2352 by 1568 pixels, CFP, 45° field of view: 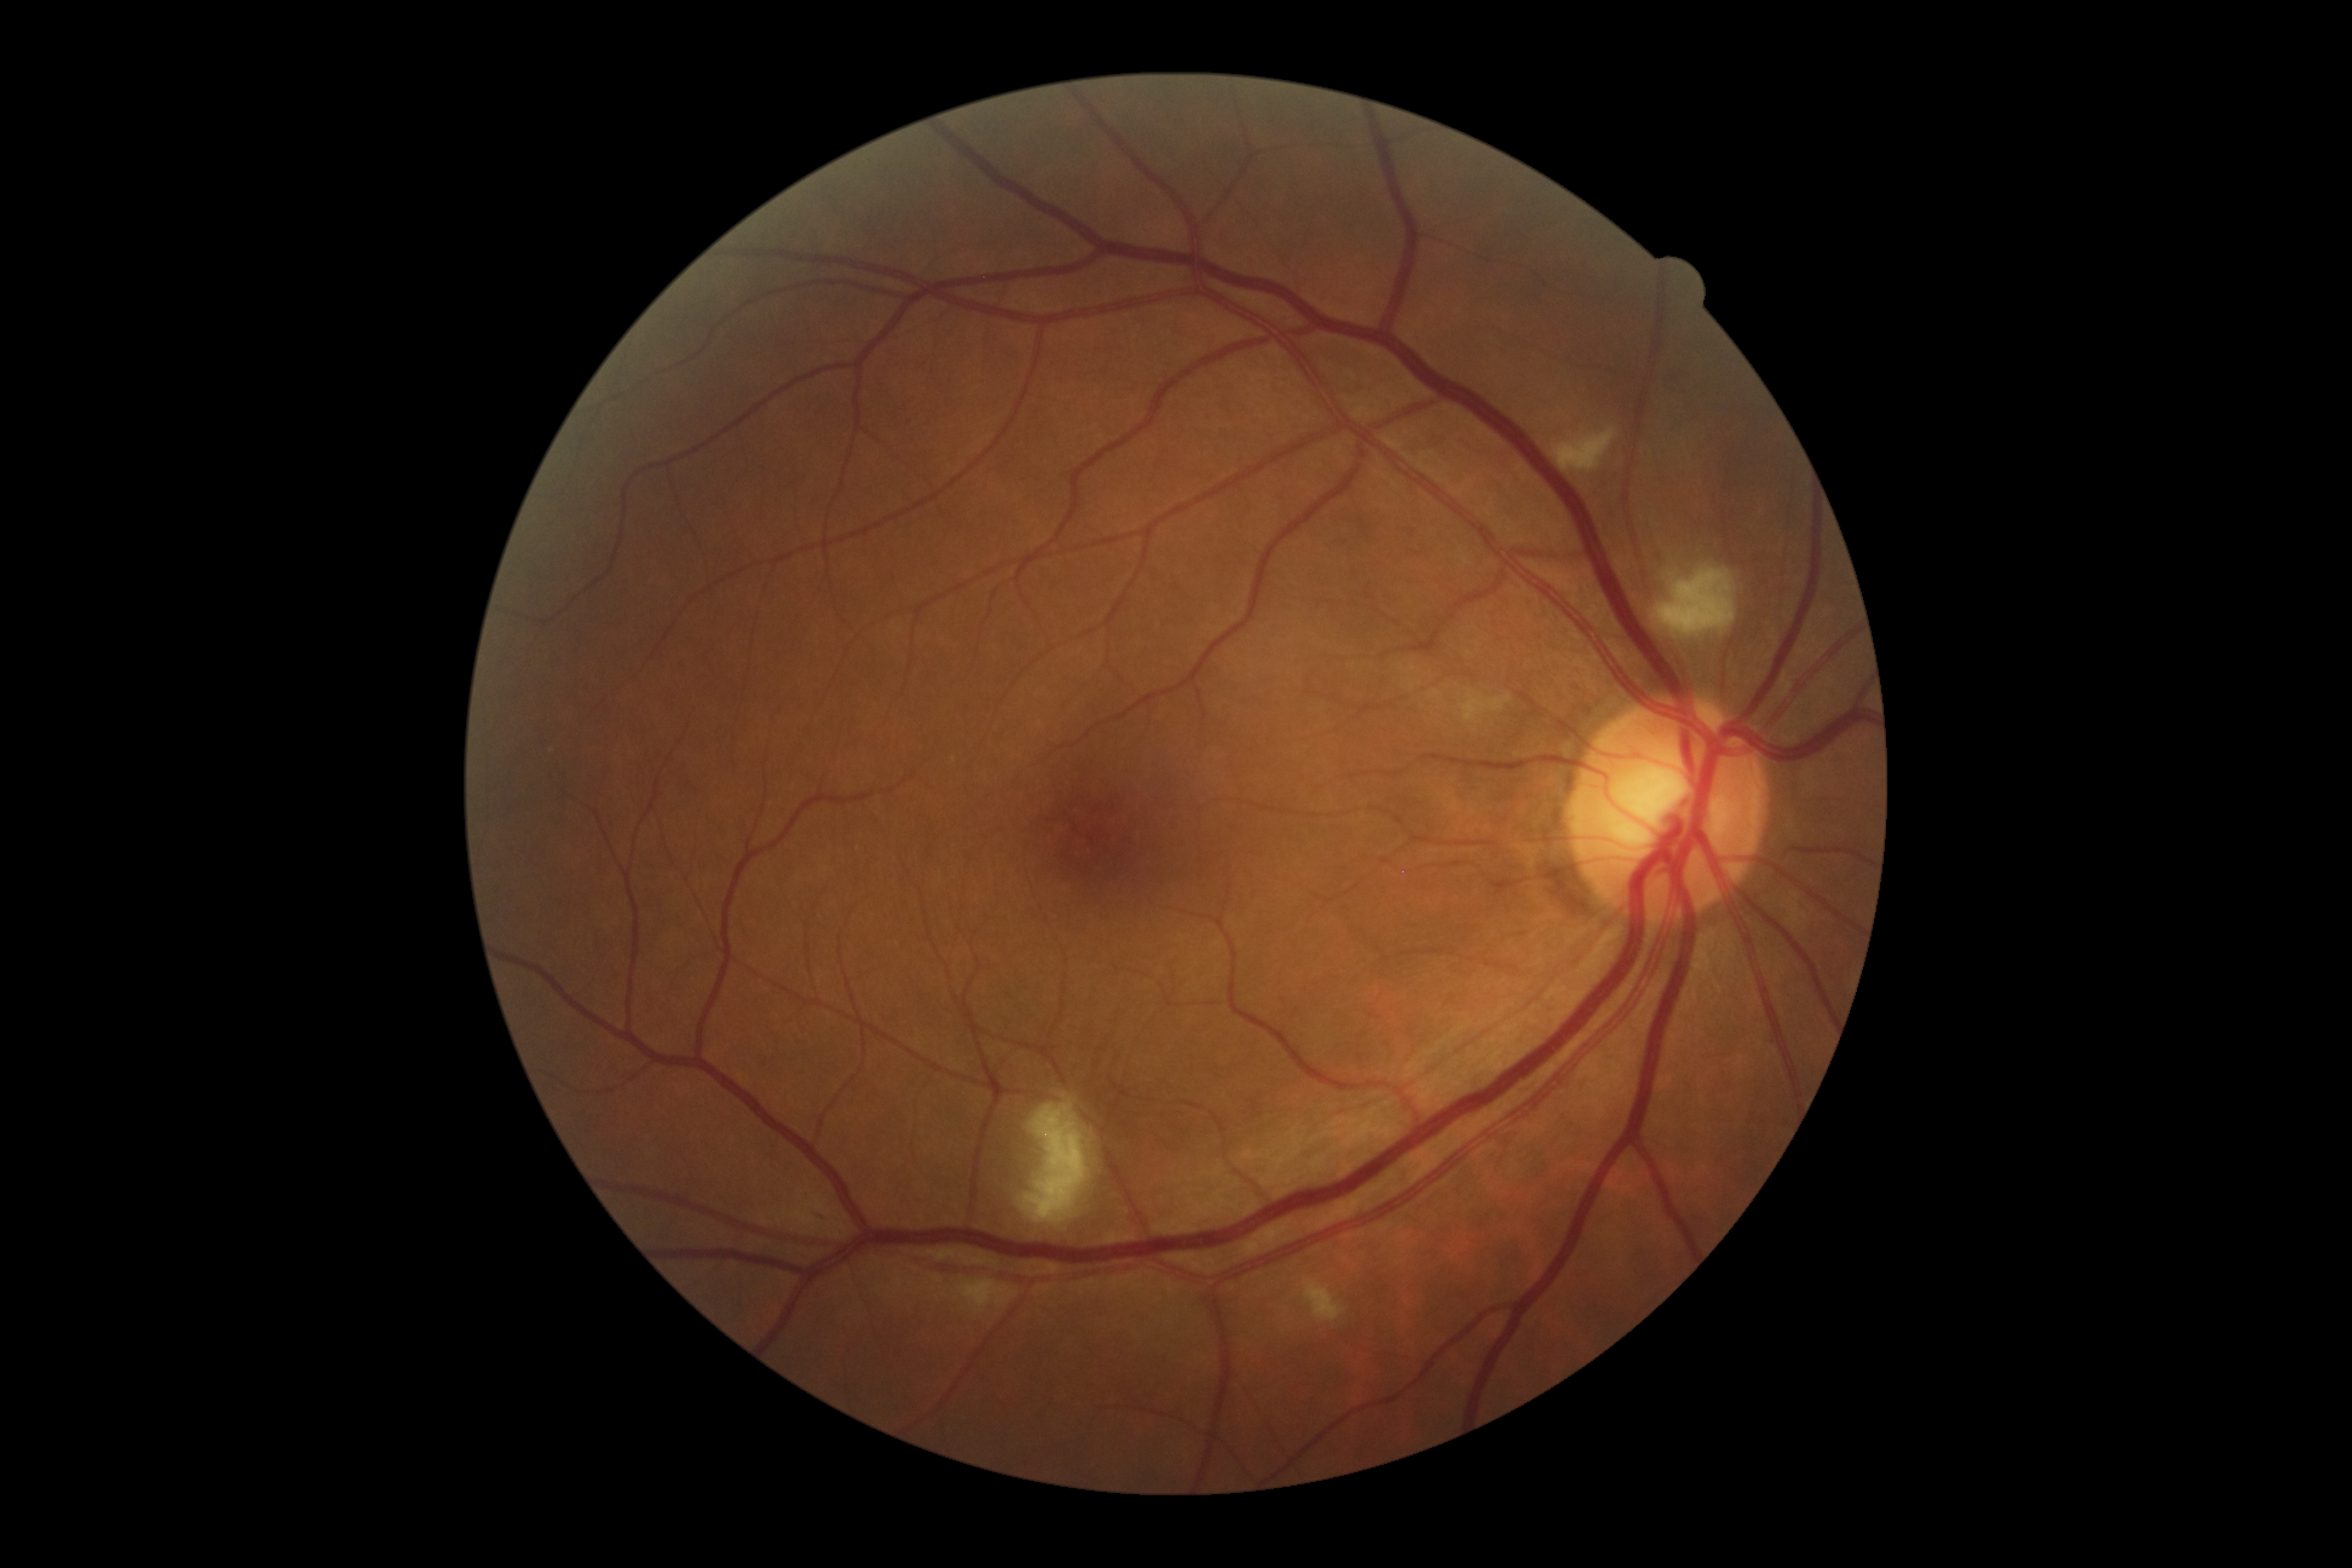
Disease class: non-proliferative diabetic retinopathy. Retinopathy: 2/4.